Retinal fundus photograph: 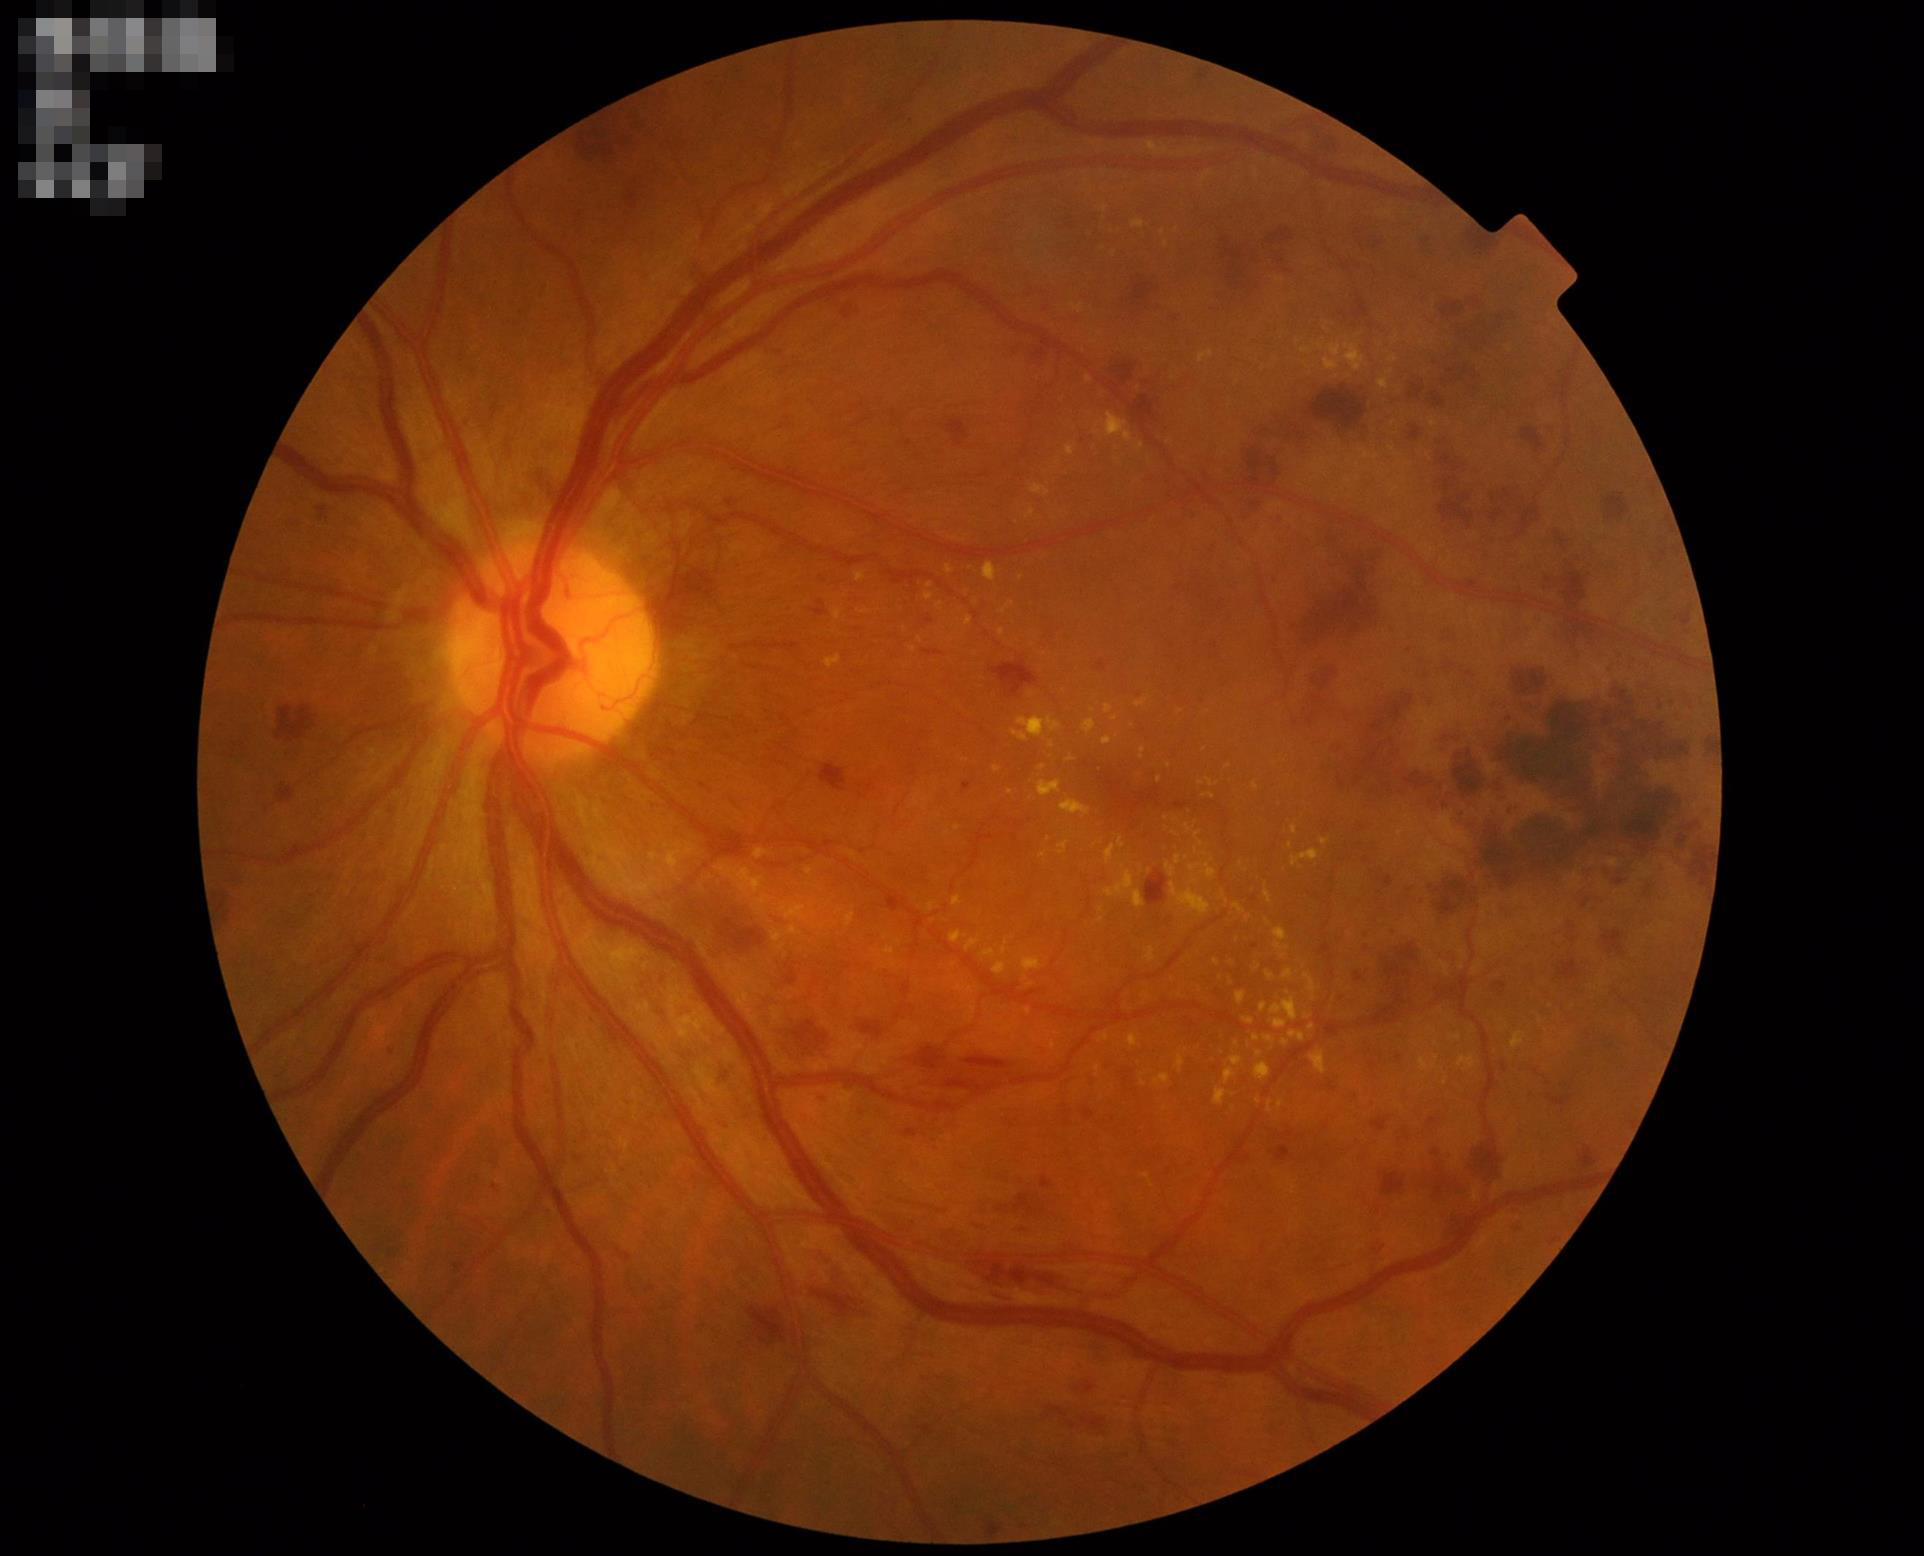 Image quality is adequate for diagnostic use.
Contrast is good.
Illumination and color balance are good.